Color fundus photograph.
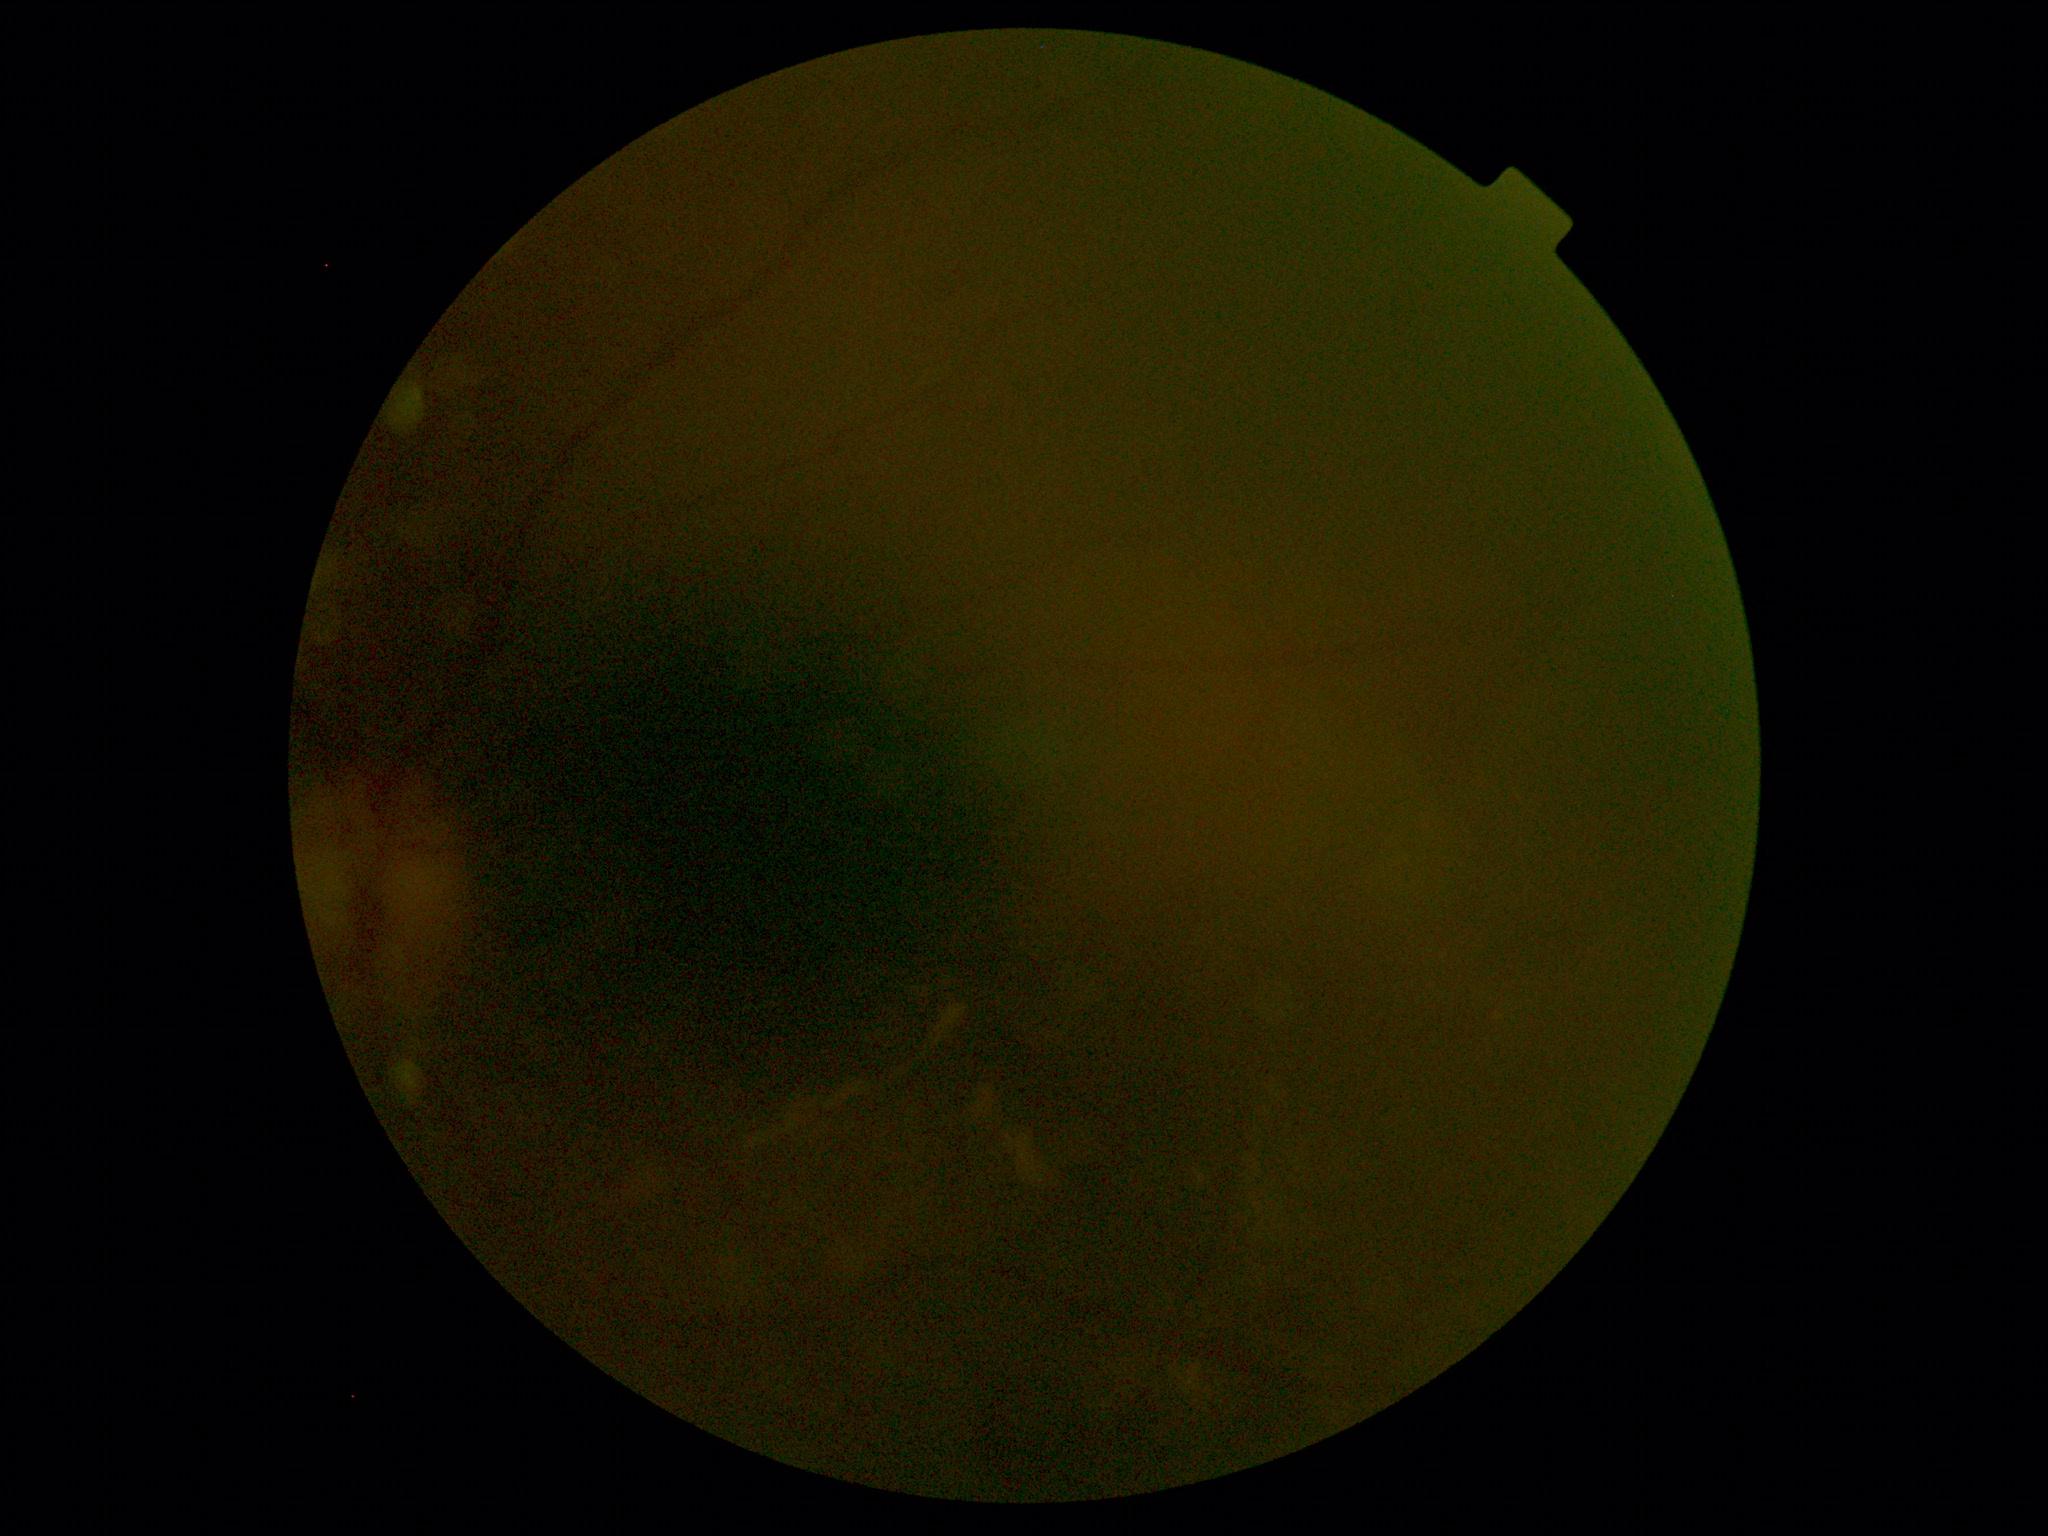 Image quality is insufficient for diabetic retinopathy assessment. Diabetic retinopathy: ungradable.